45-degree field of view; color fundus image; 2352x1568px:
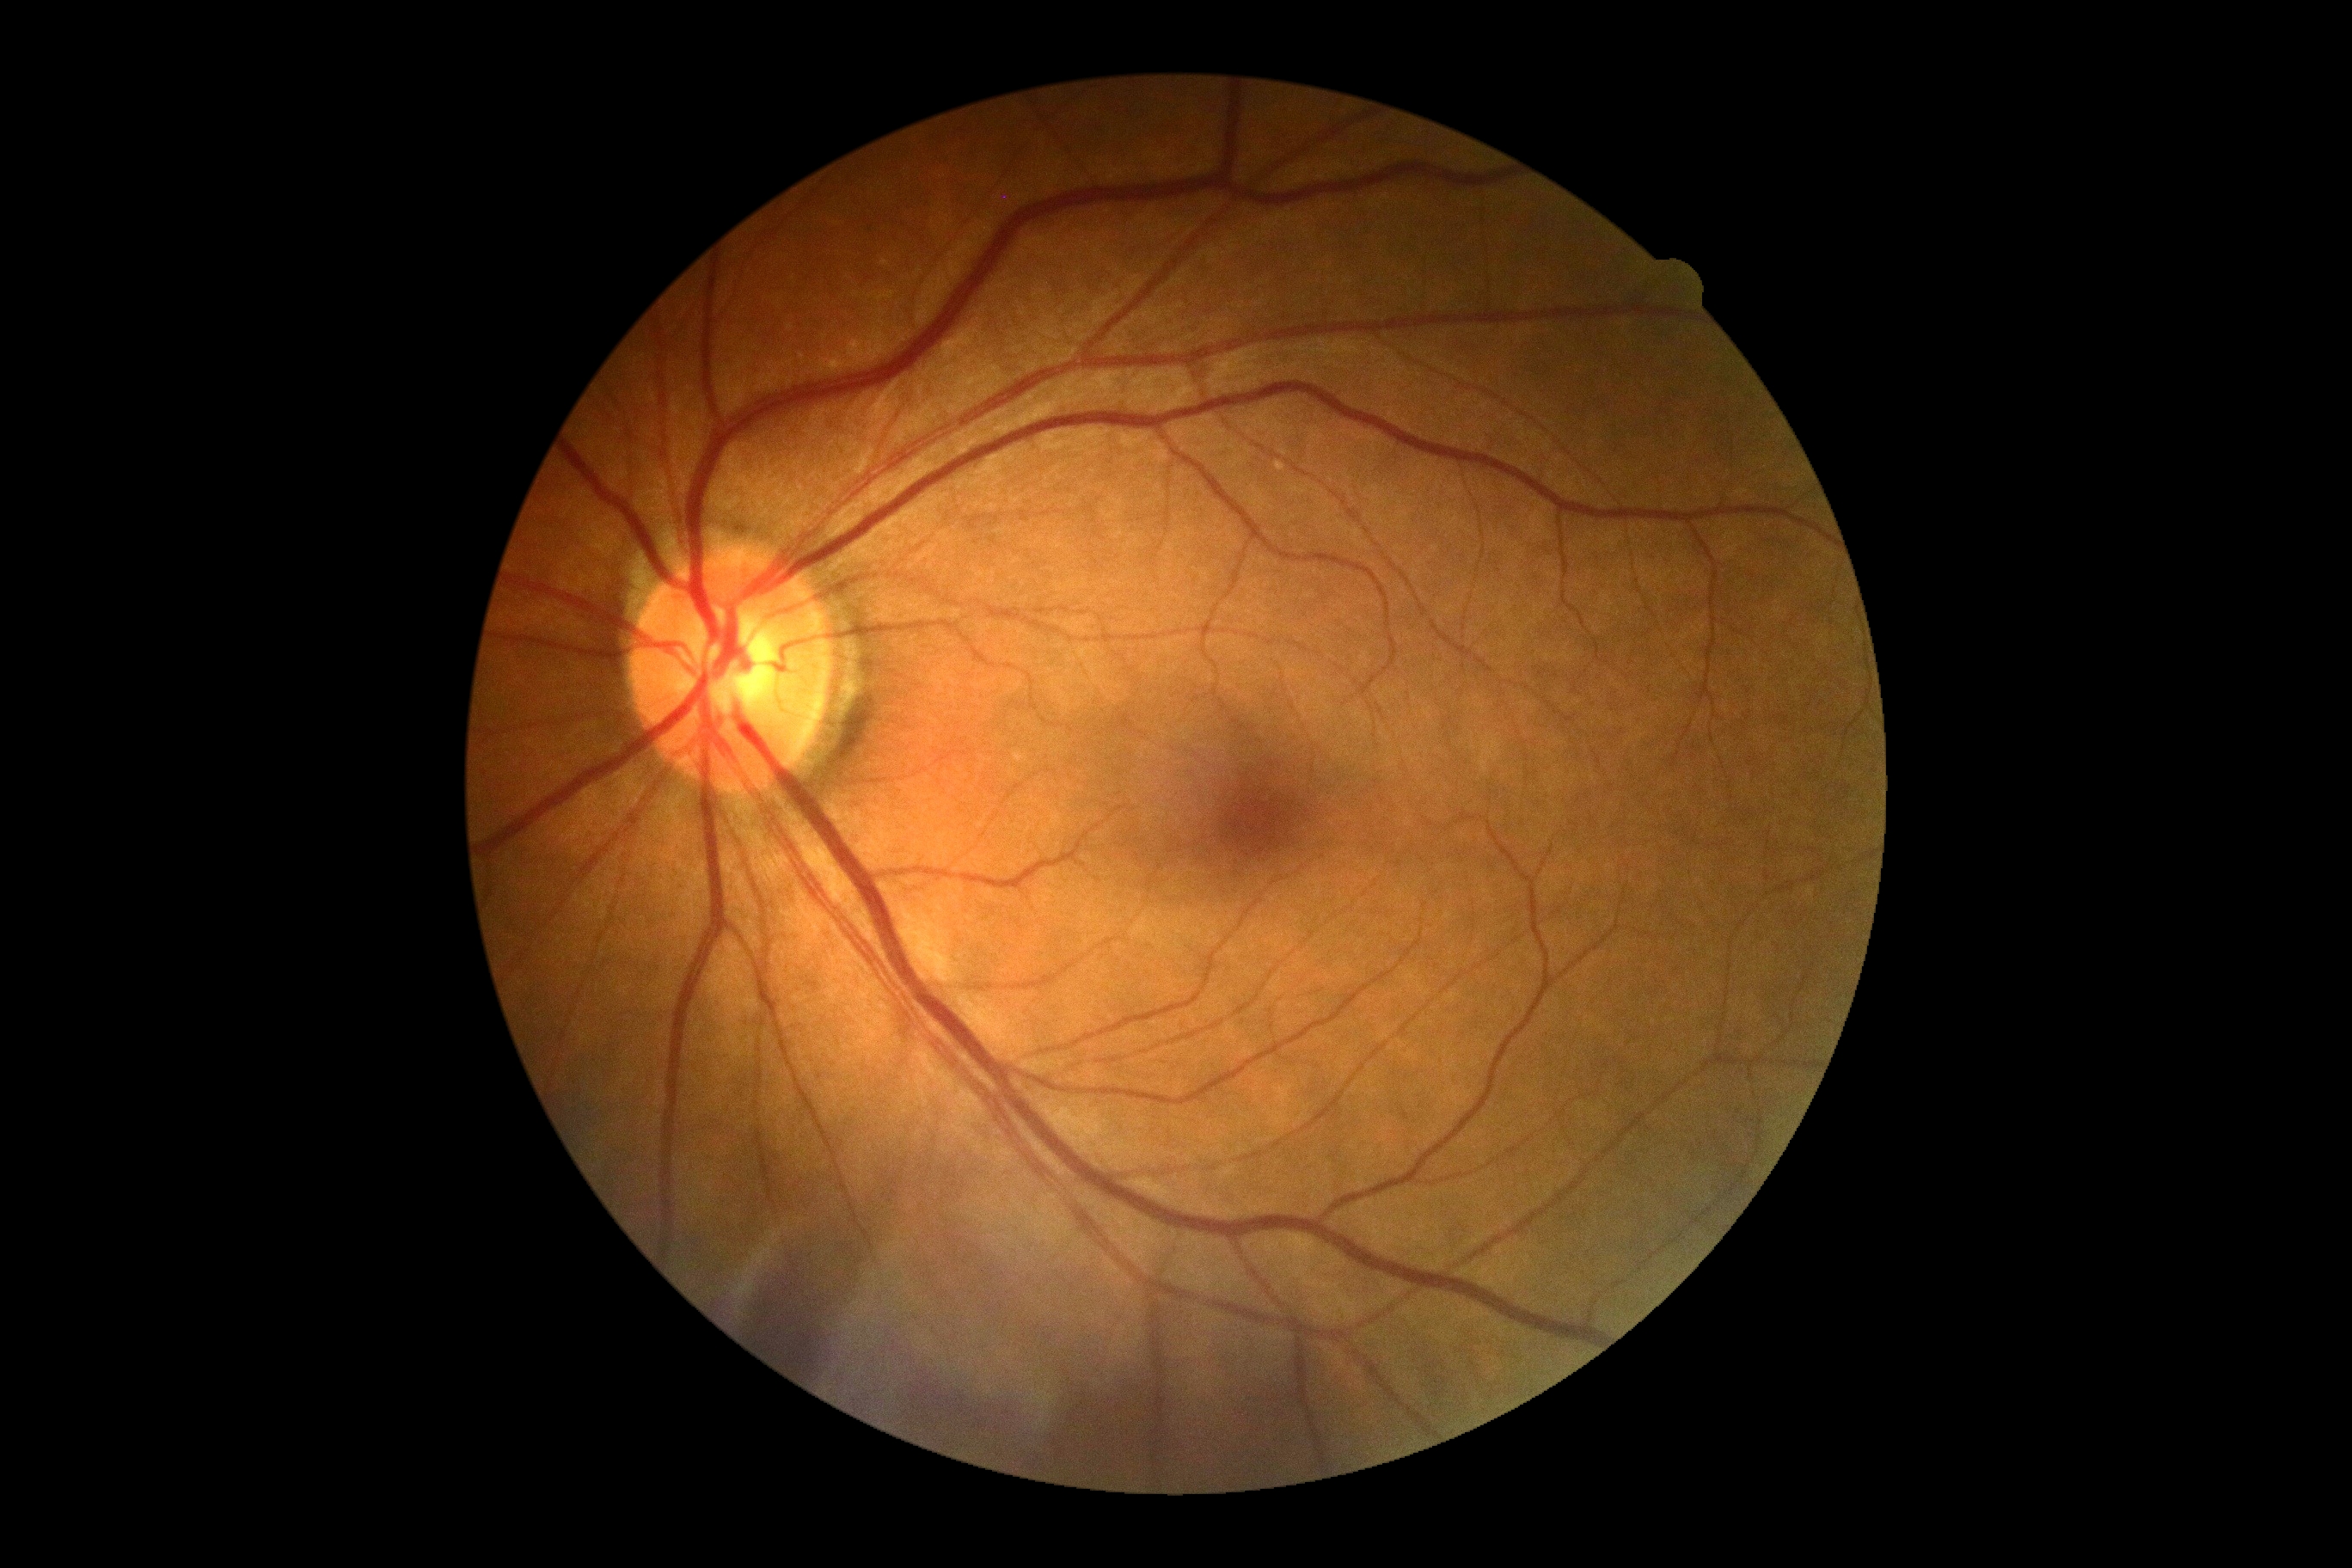 Findings:
- DR impression: no signs of DR
- DR grade: 0